Infant wide-field retinal image; 640x480px — 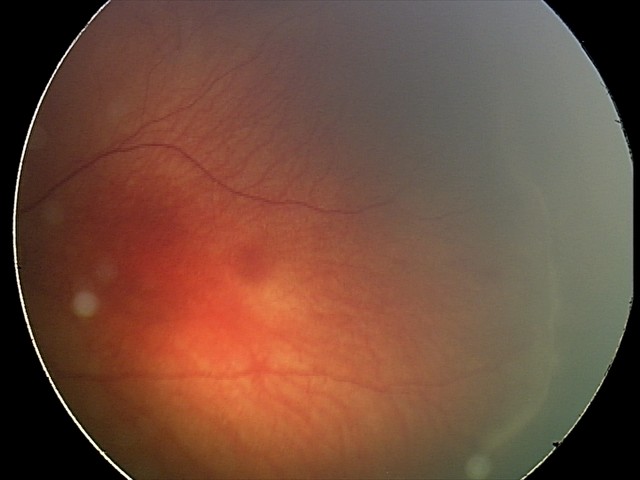
Series diagnosed as retinopathy of prematurity stage 2.
Without plus disease.